Optic nerve head photograph; 35° FOV before cropping: 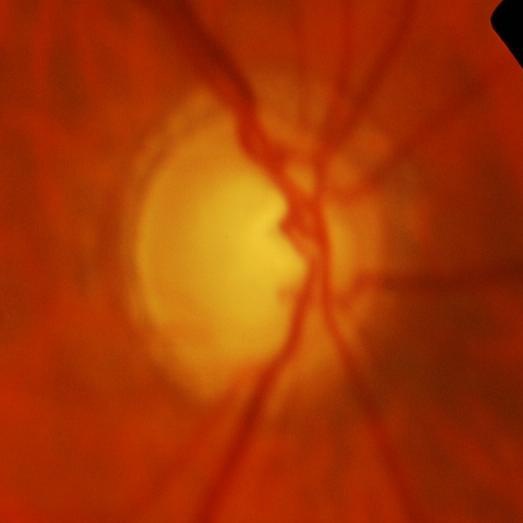

Optic disc appearance consistent with glaucomatous findings.